1932 x 1916 pixels.
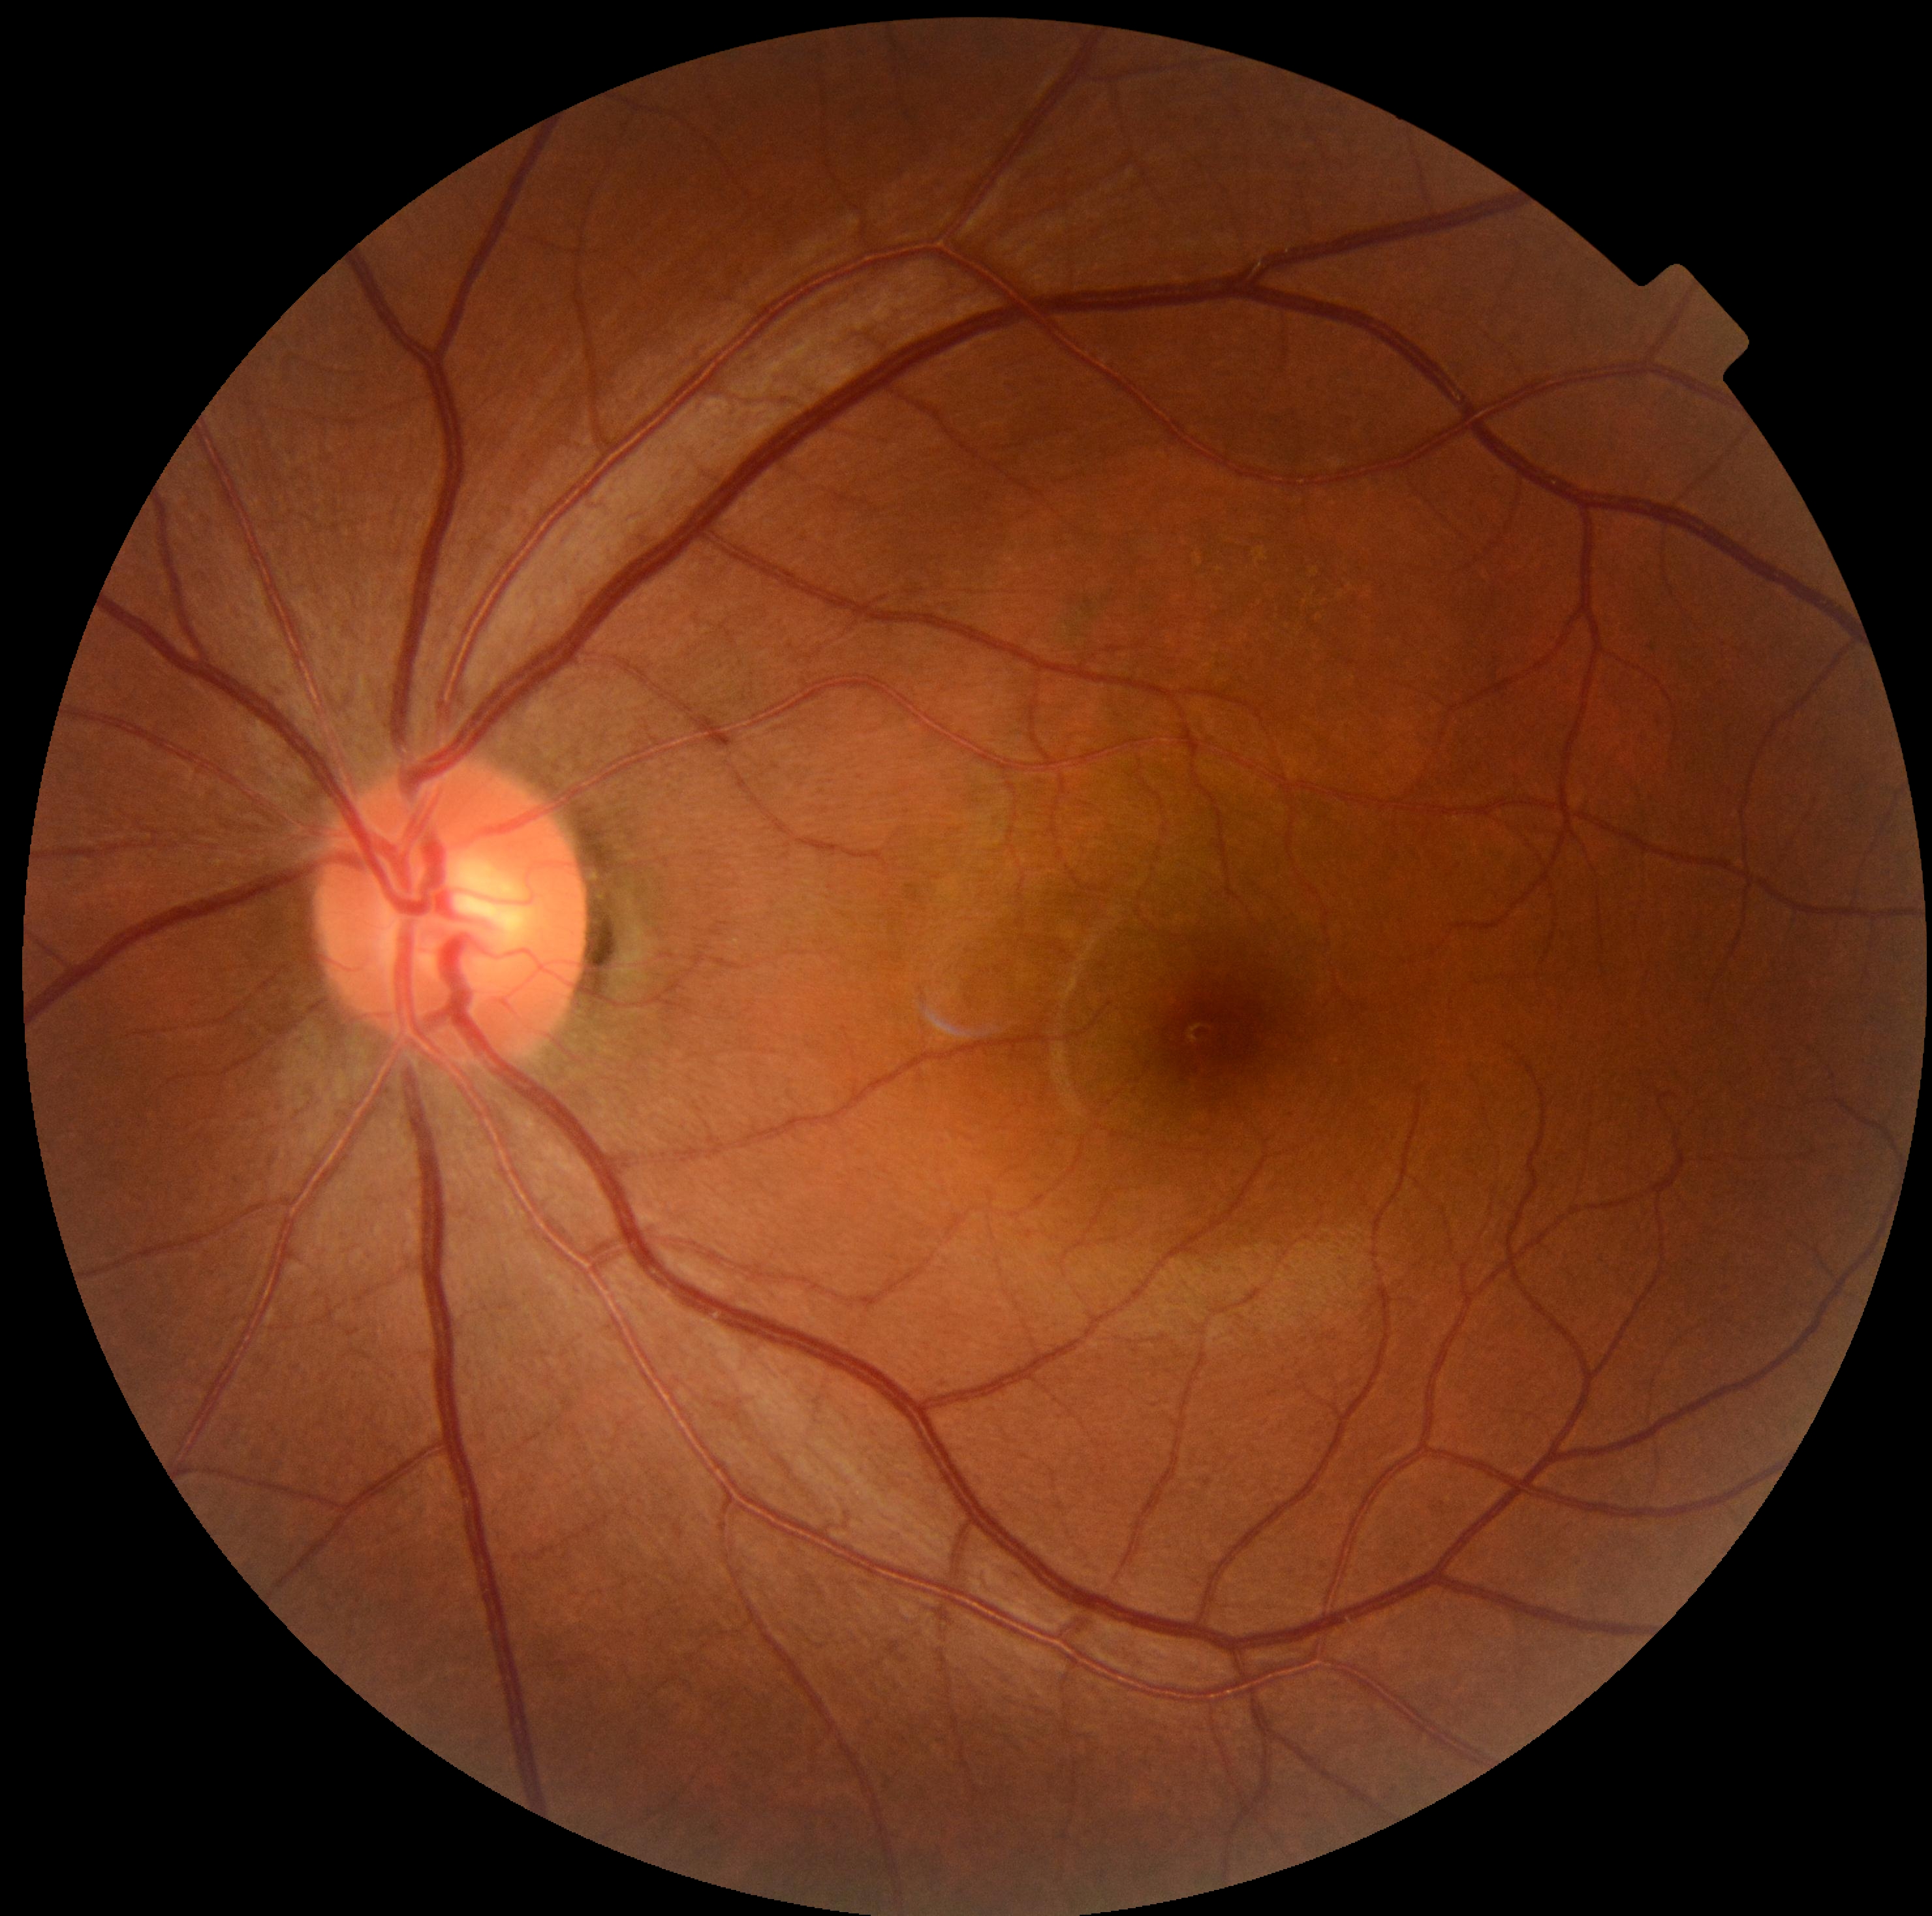

DR grade is 0/4.